640 x 480 pixels; pediatric retinal photograph (wide-field): 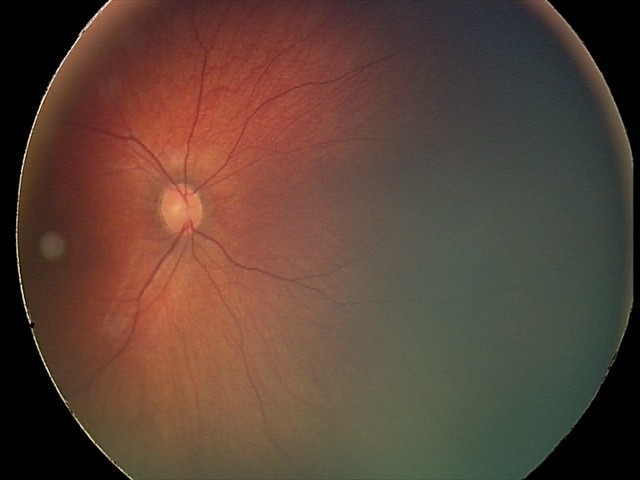

Examination diagnosed as retinal hemorrhages.